Color fundus image. 2212 by 1672 pixels:
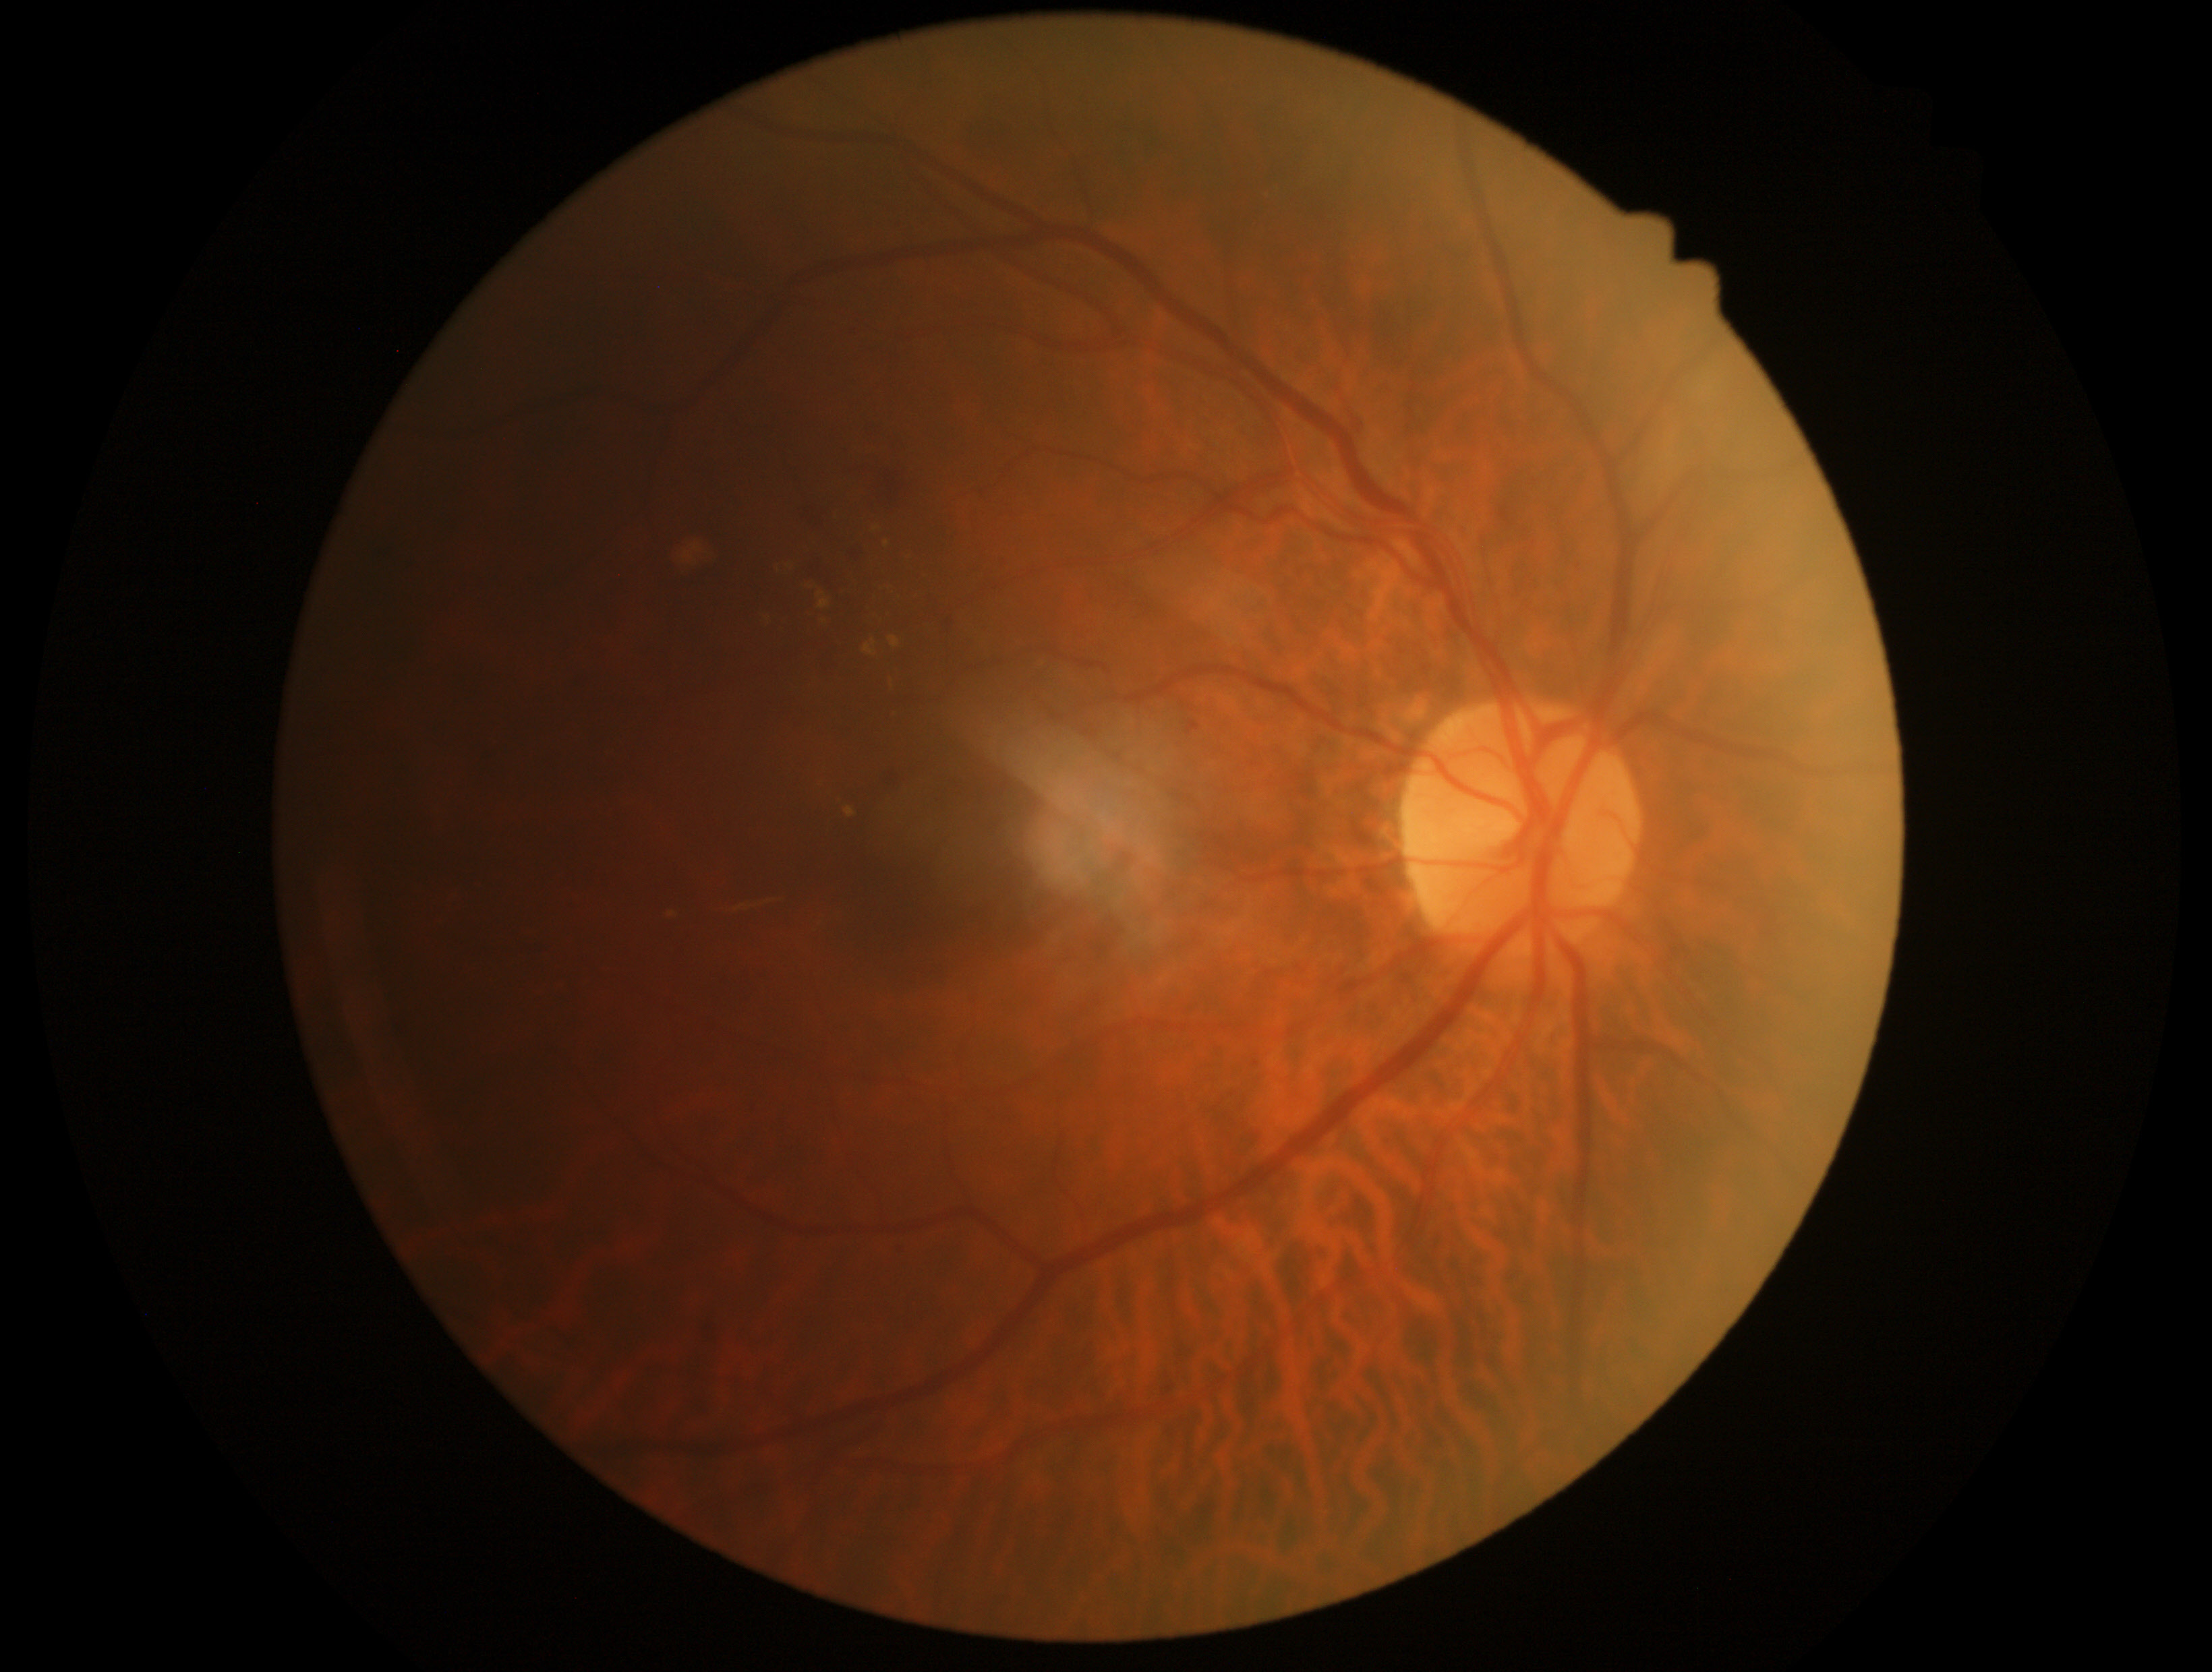

DR grade: moderate NPDR (2) — more than just microaneurysms but less than severe NPDR.